Optic disc photograph: 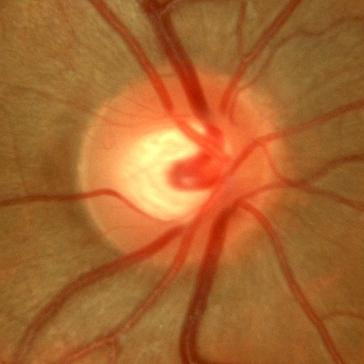
Findings consistent with no glaucoma.